2352 by 1568 pixels, retinal fundus photograph, FOV: 45 degrees: 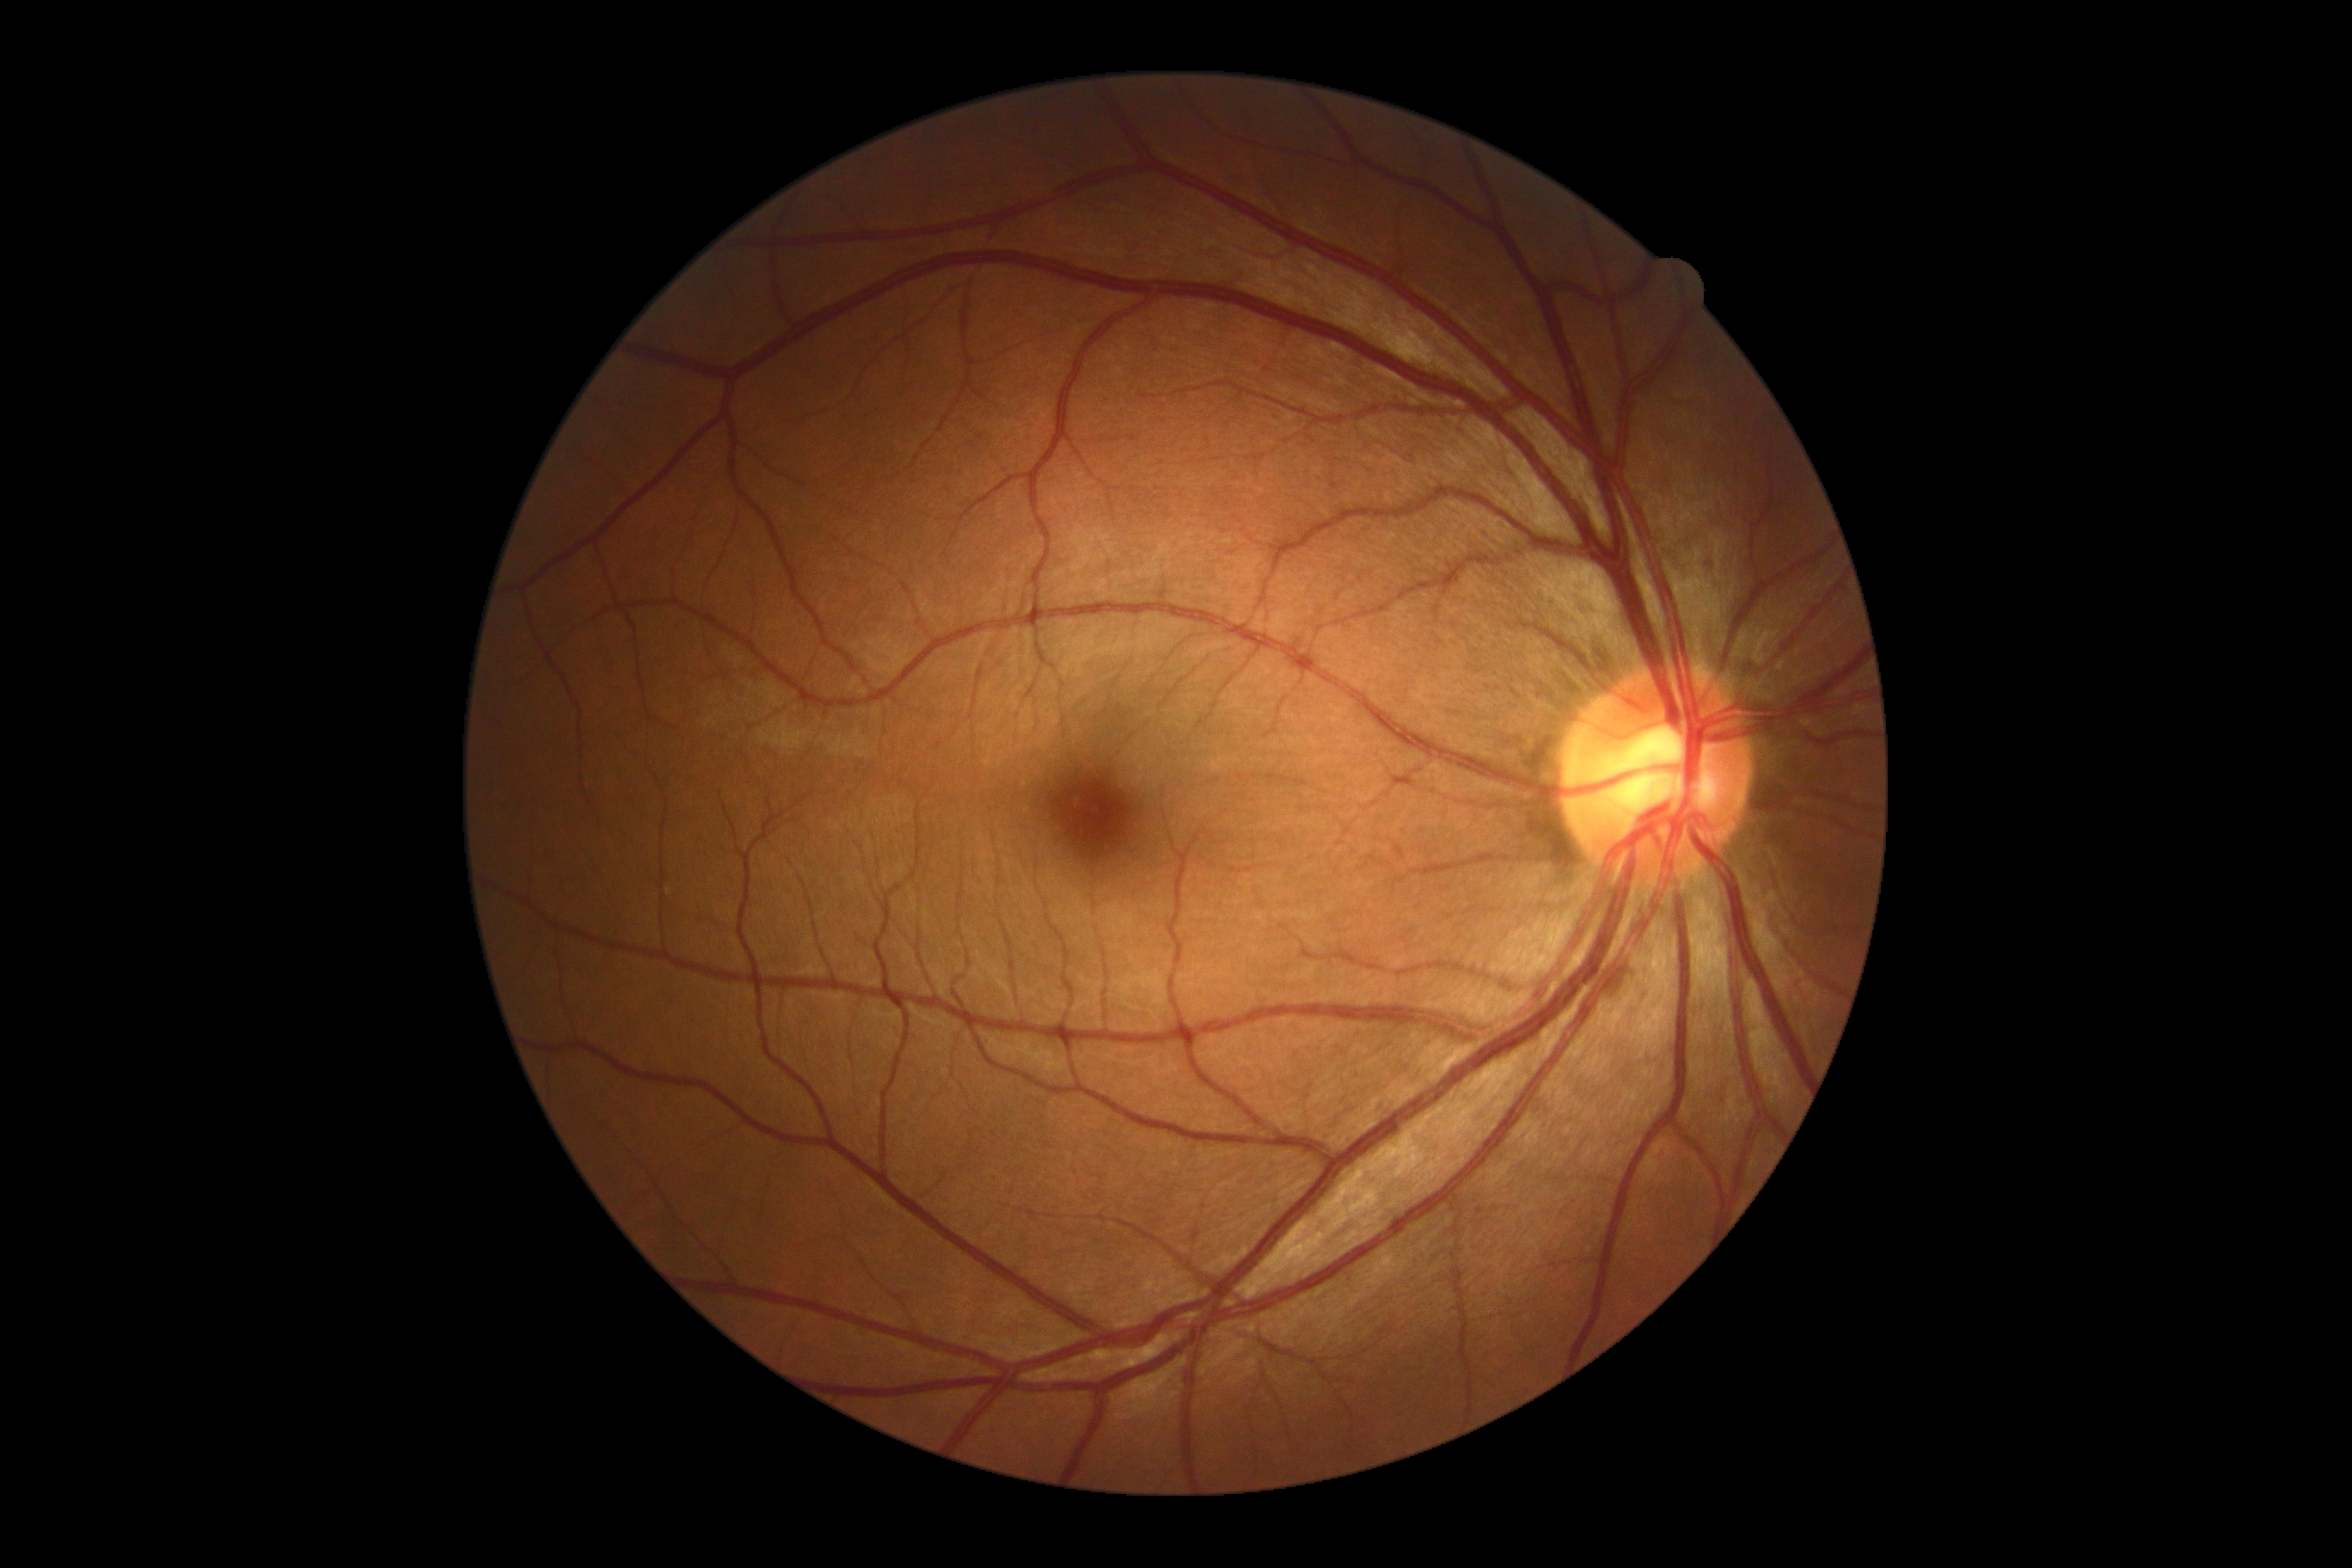 {
  "dr_grade": "0/4"
}